2048 x 1536 pixels:
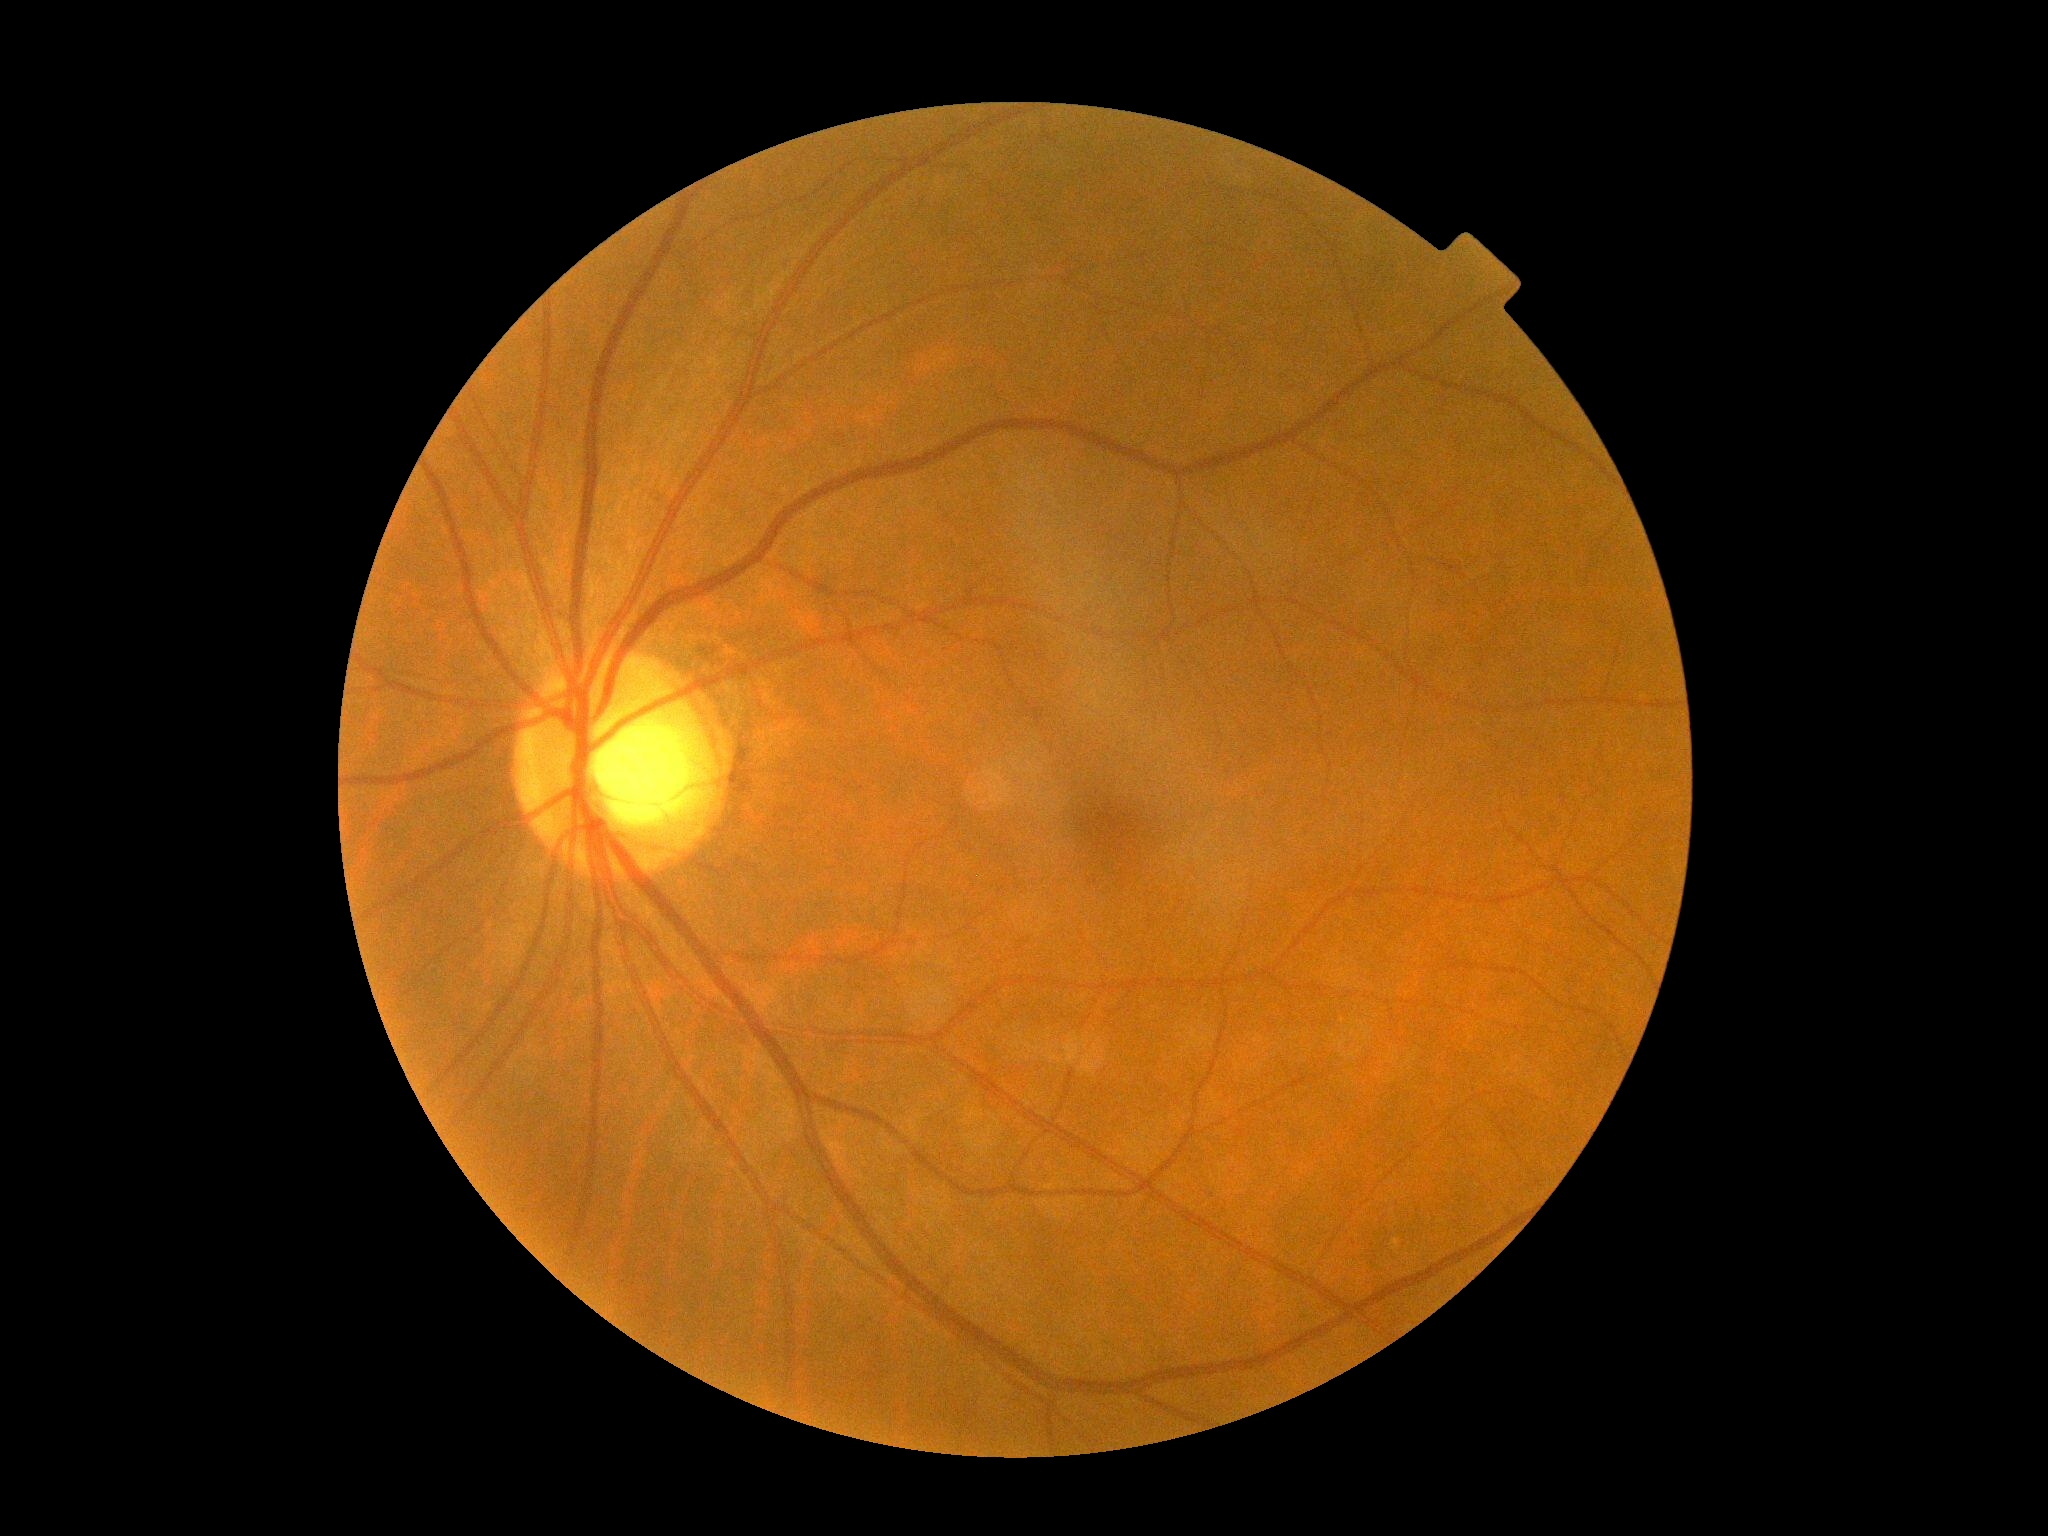 {
  "dr_grade": "0"
}